640 x 480 pixels. Acquired on the Clarity RetCam 3. Wide-field contact fundus photograph of an infant.
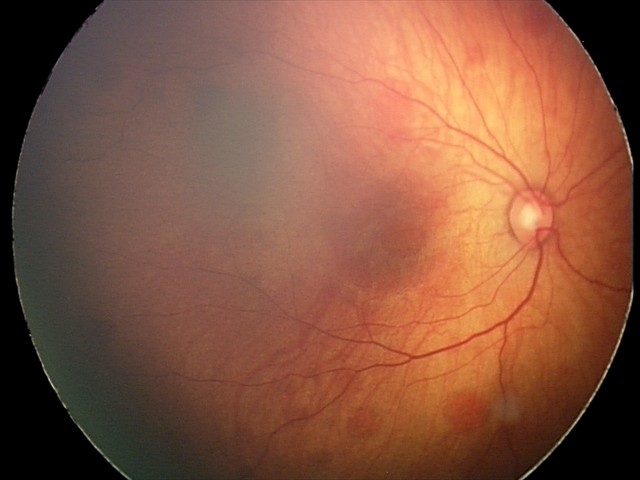

Examination diagnosed as retinal hemorrhages.